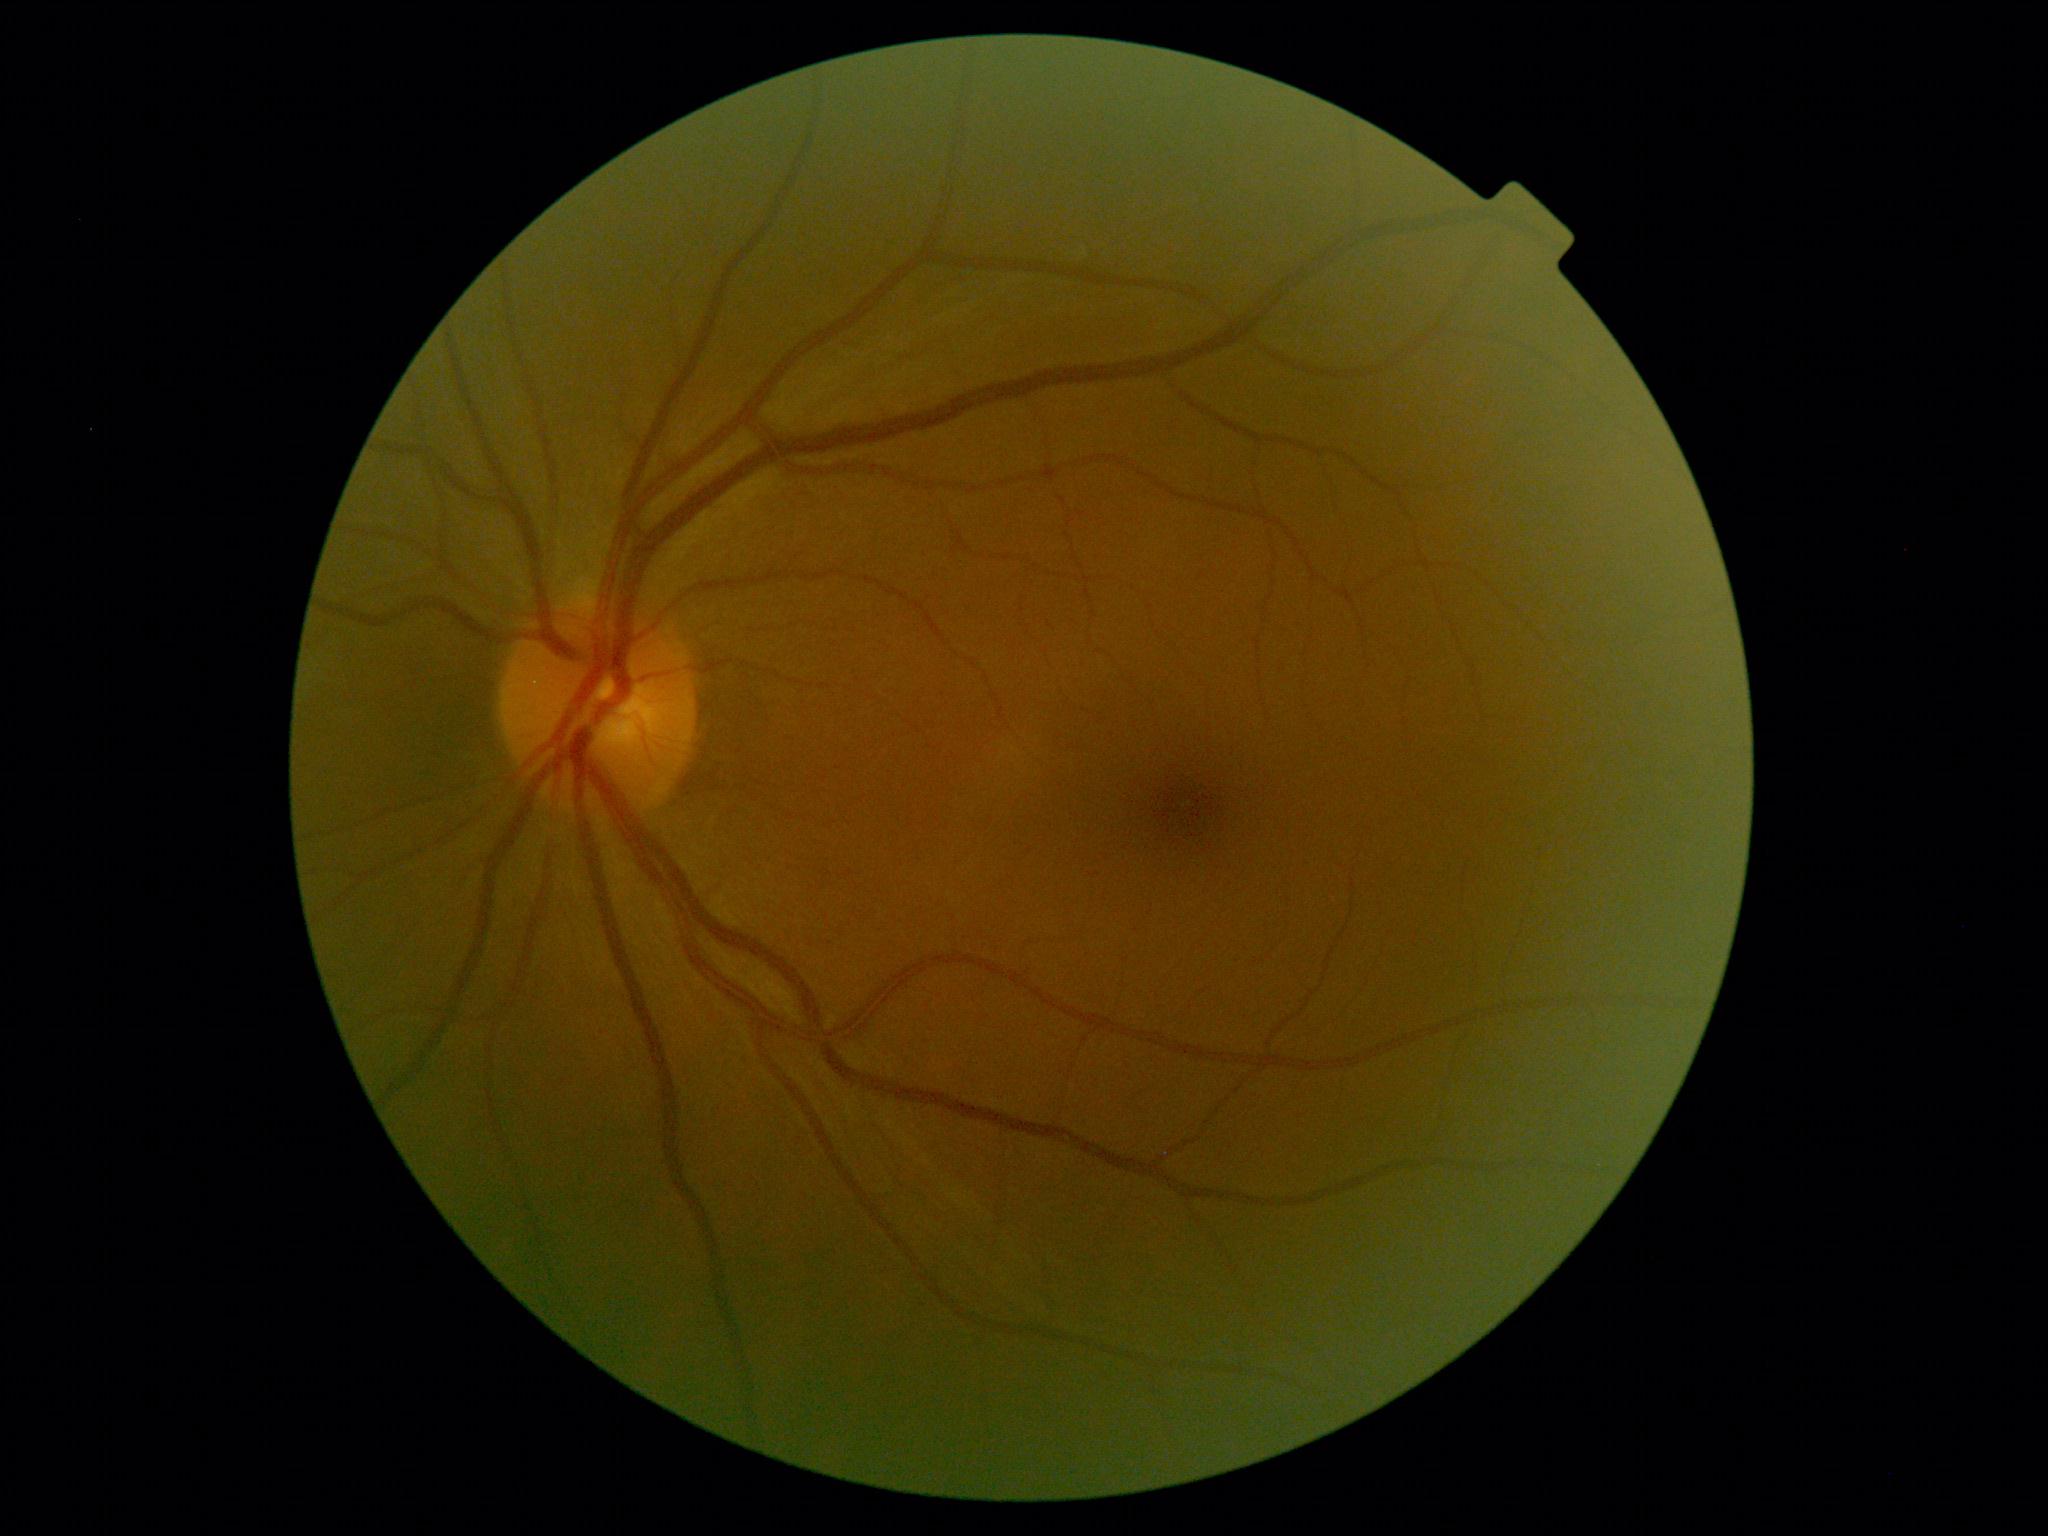

  dr_grade: no apparent retinopathy (0)
  dr_impression: no DR findings